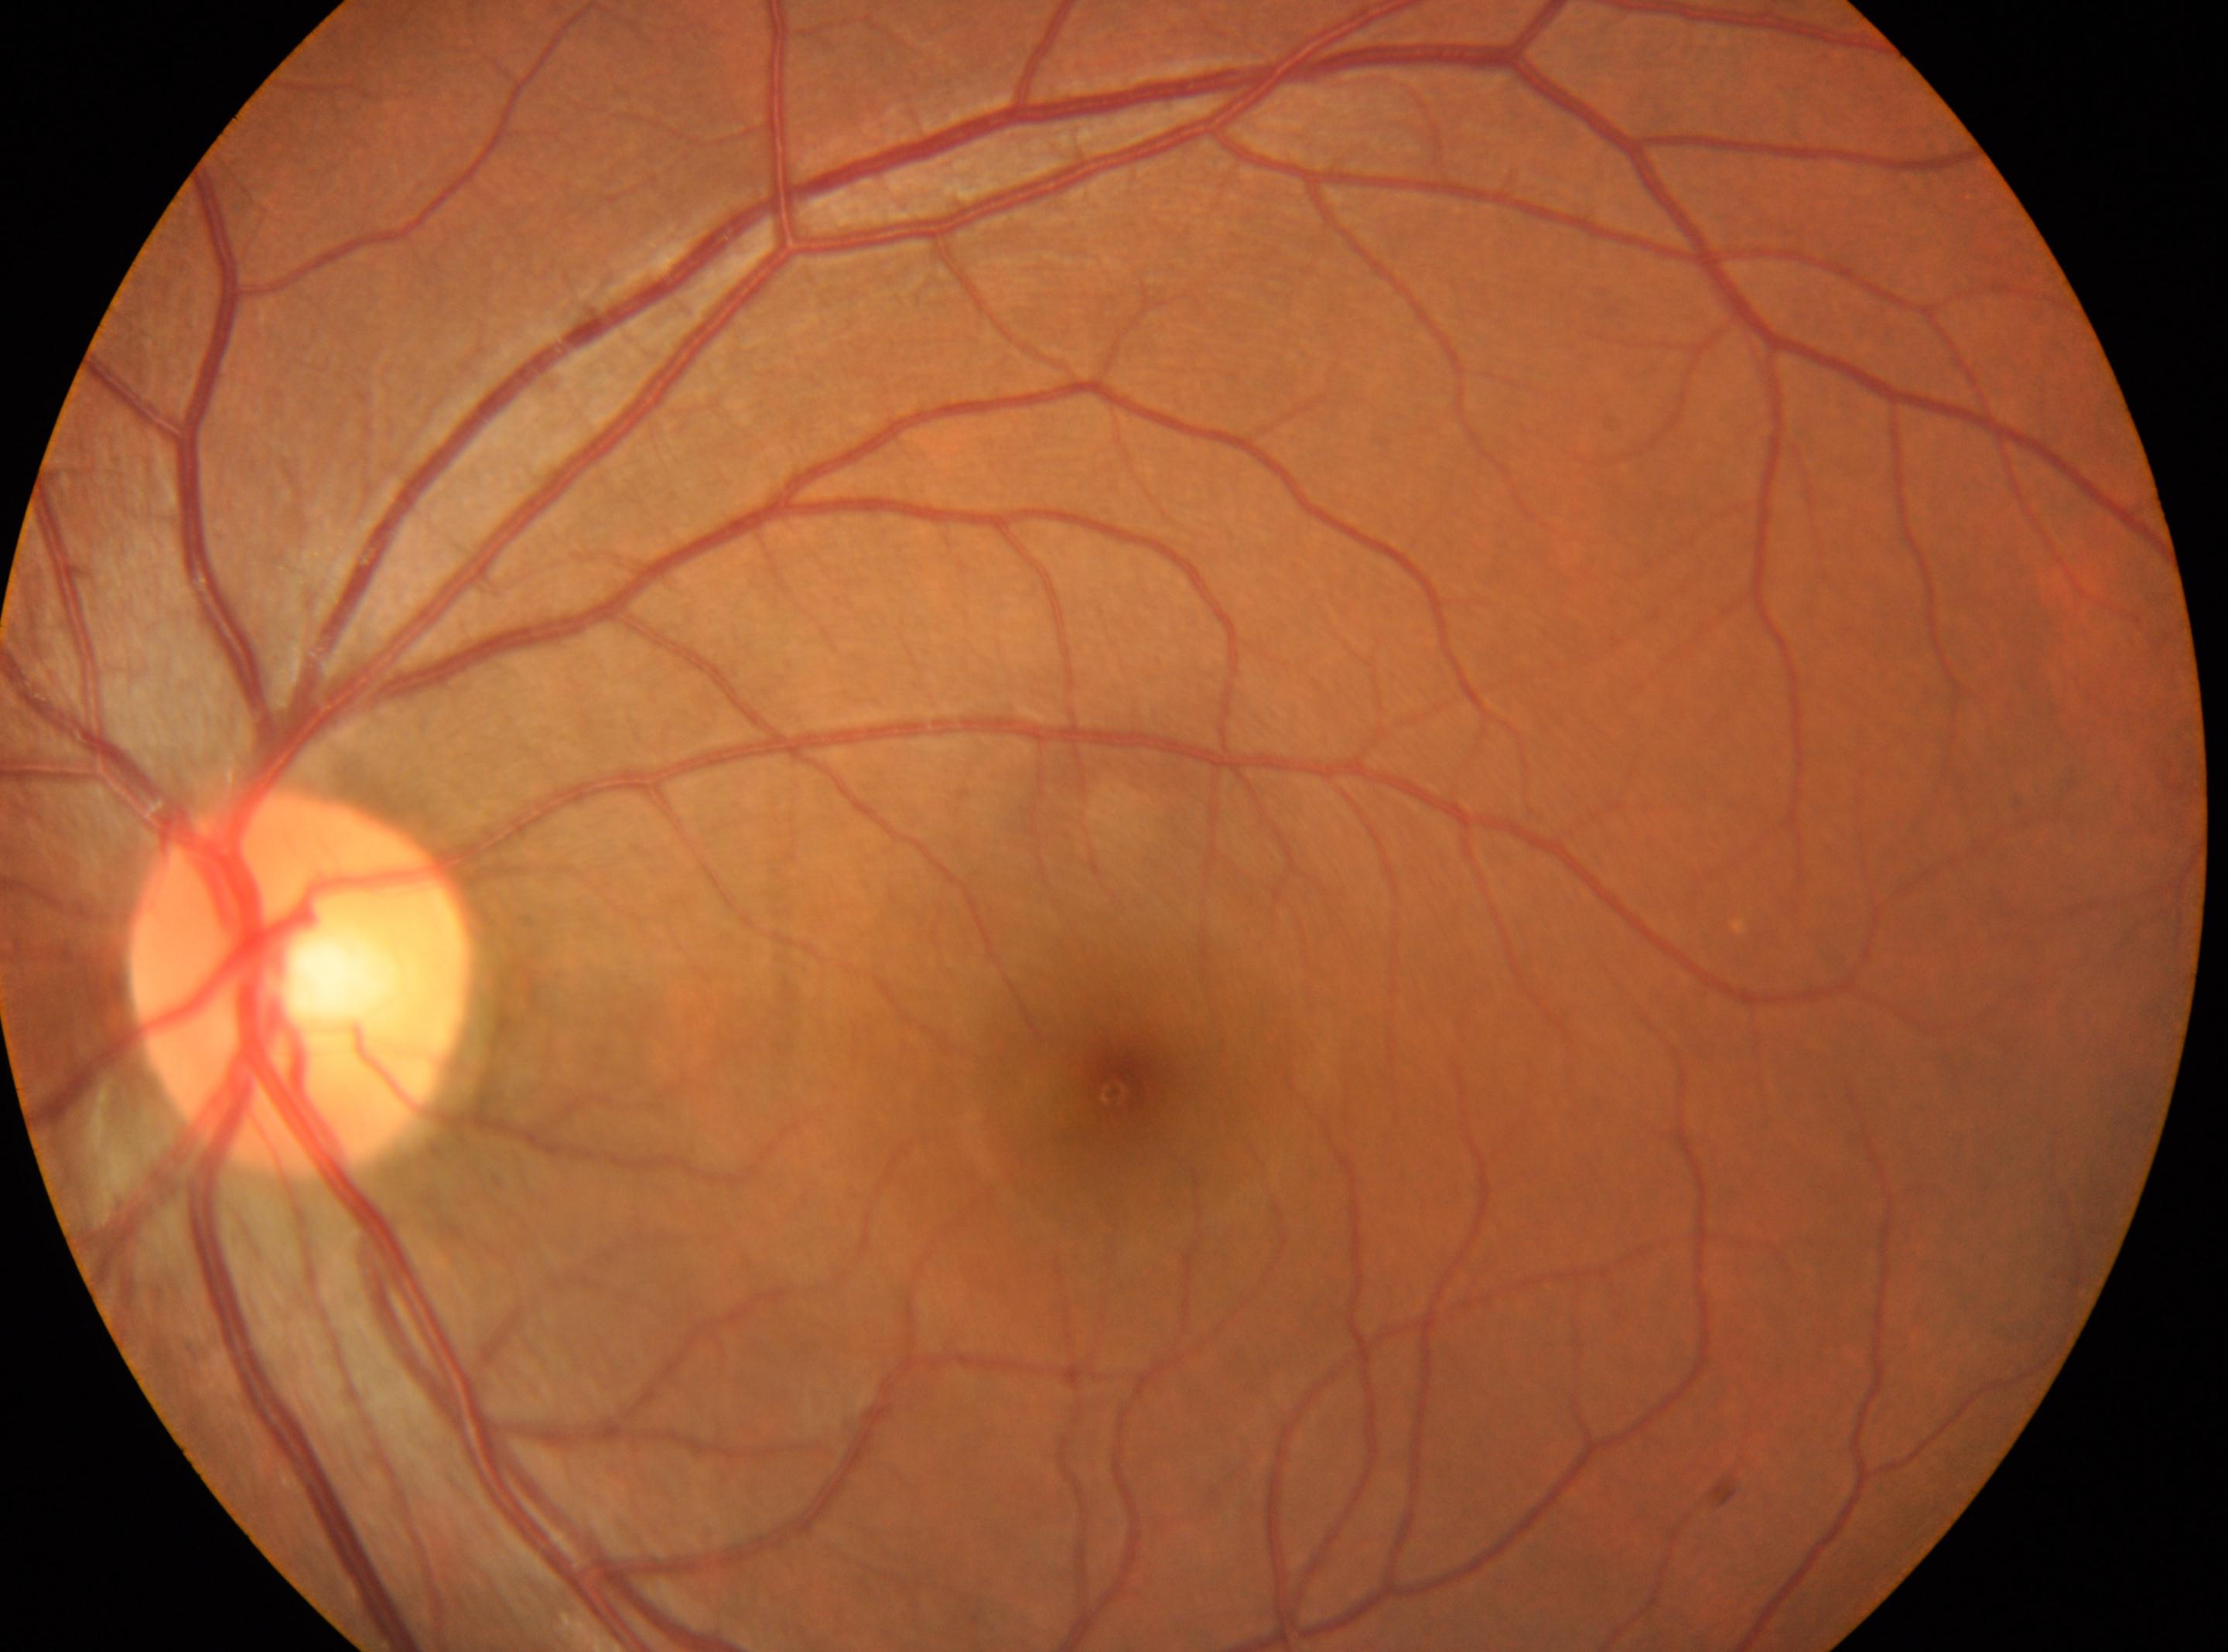

Disc center: (x: 299, y: 981).
The image shows the left eye.
DR: grade 0 (no apparent retinopathy).
Fovea center: (x: 1120, y: 1092).